Retinal fundus photograph.
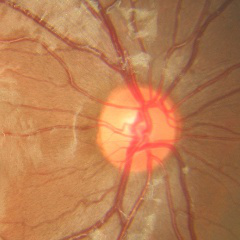

Showing no glaucoma.